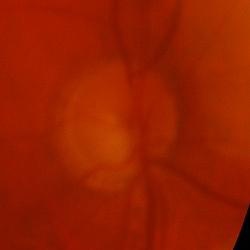

This optic disc photograph shows glaucomatous damage to the optic nerve.